Camera: Clarity RetCam 3 (130° FOV). Wide-field fundus photograph of an infant
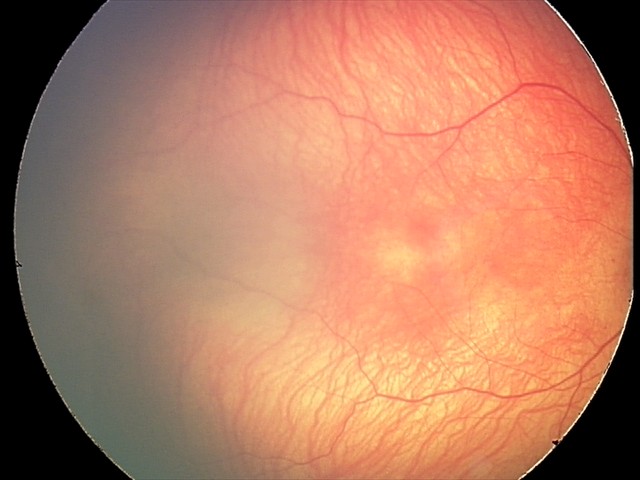

Screening: ROP stage 1 | no plus disease.